Field includes the optic disc and macula. 2228 by 1652 pixels. Mydriatic (tropicamide and phenylephrine). Acquired with a Topcon TRC-50DX. 50-degree field of view: 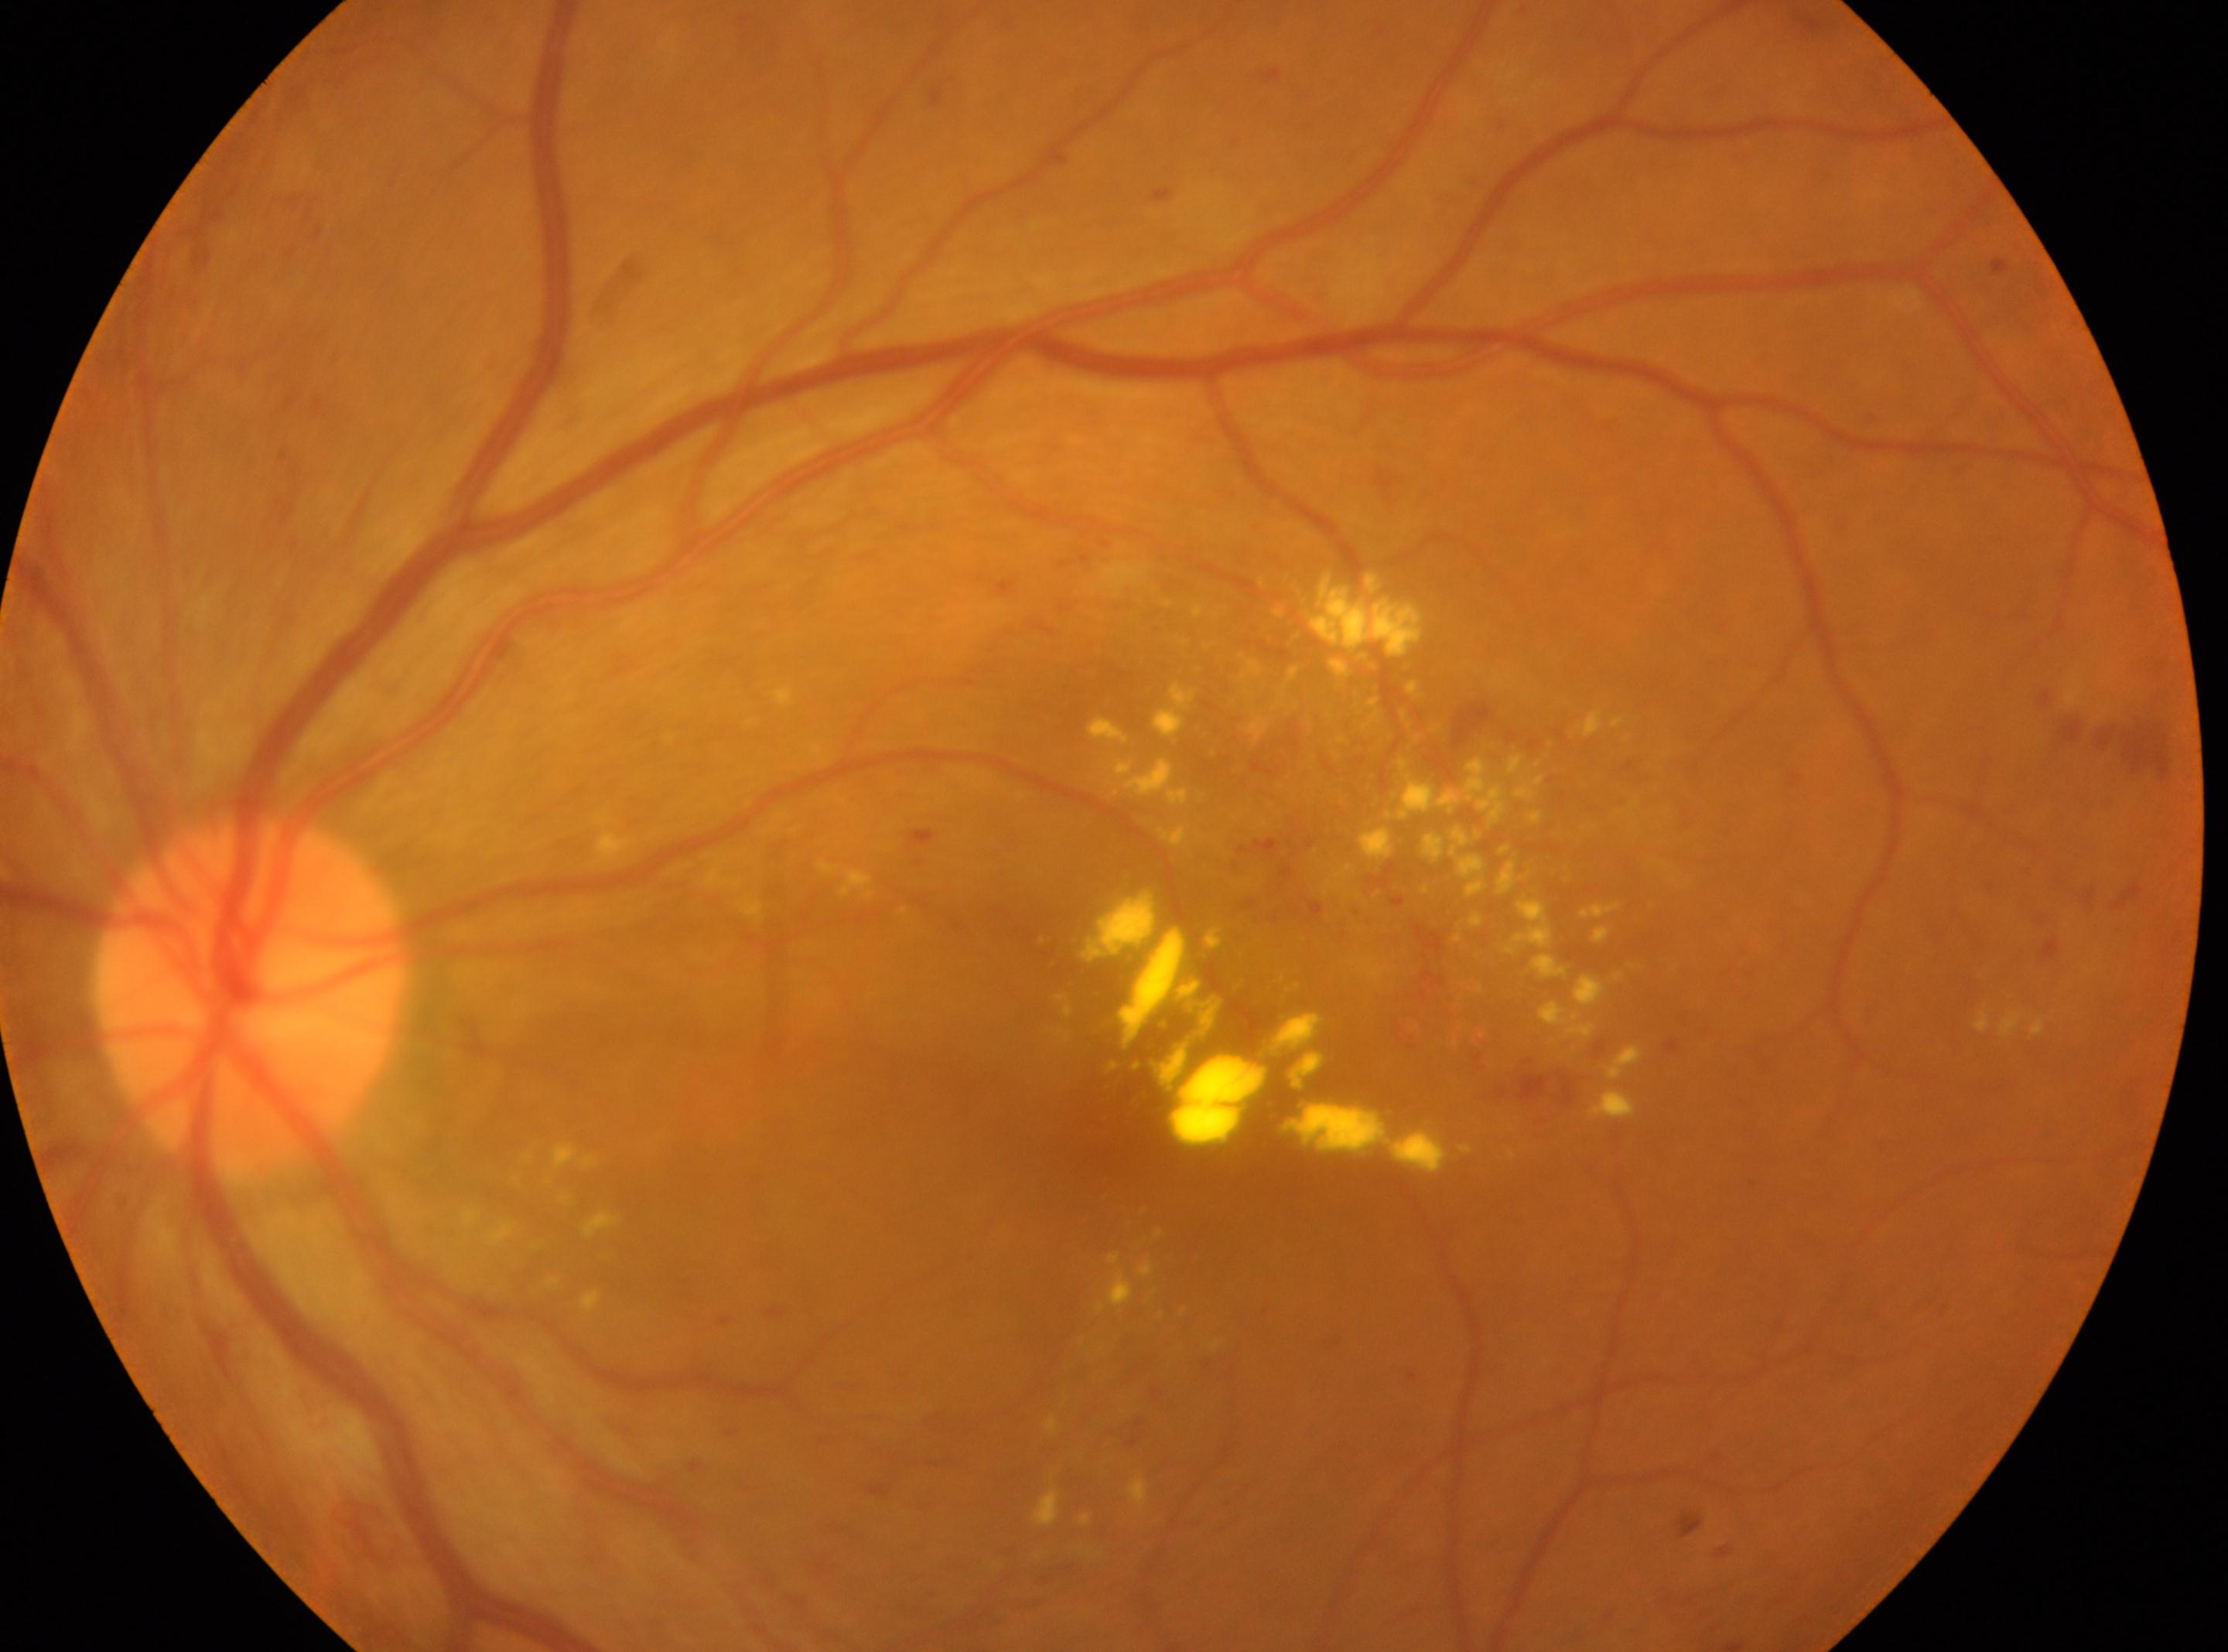

Fovea center located at 1092, 1129.
The image shows the left eye.
Diabetic retinopathy severity is grade 2 (moderate NPDR) — more than just microaneurysms but less than severe NPDR.
The ONH is at 249, 992.